Camera: Clarity RetCam 3 (130° FOV). Wide-field fundus photograph from neonatal ROP screening: 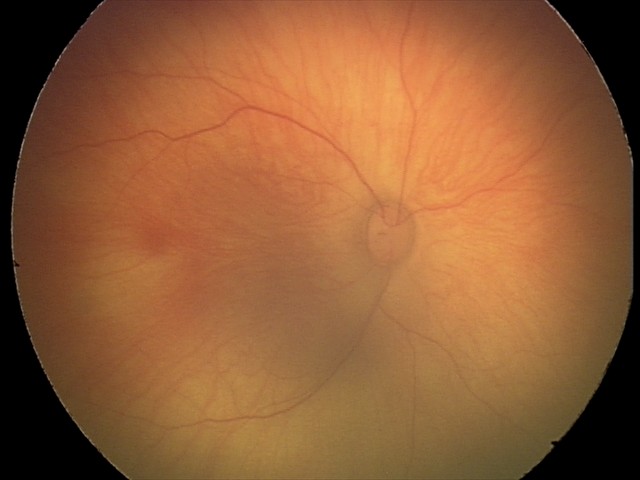

Screening series with retinal hemorrhages.